Color fundus photograph. 1659 by 2212 pixels — 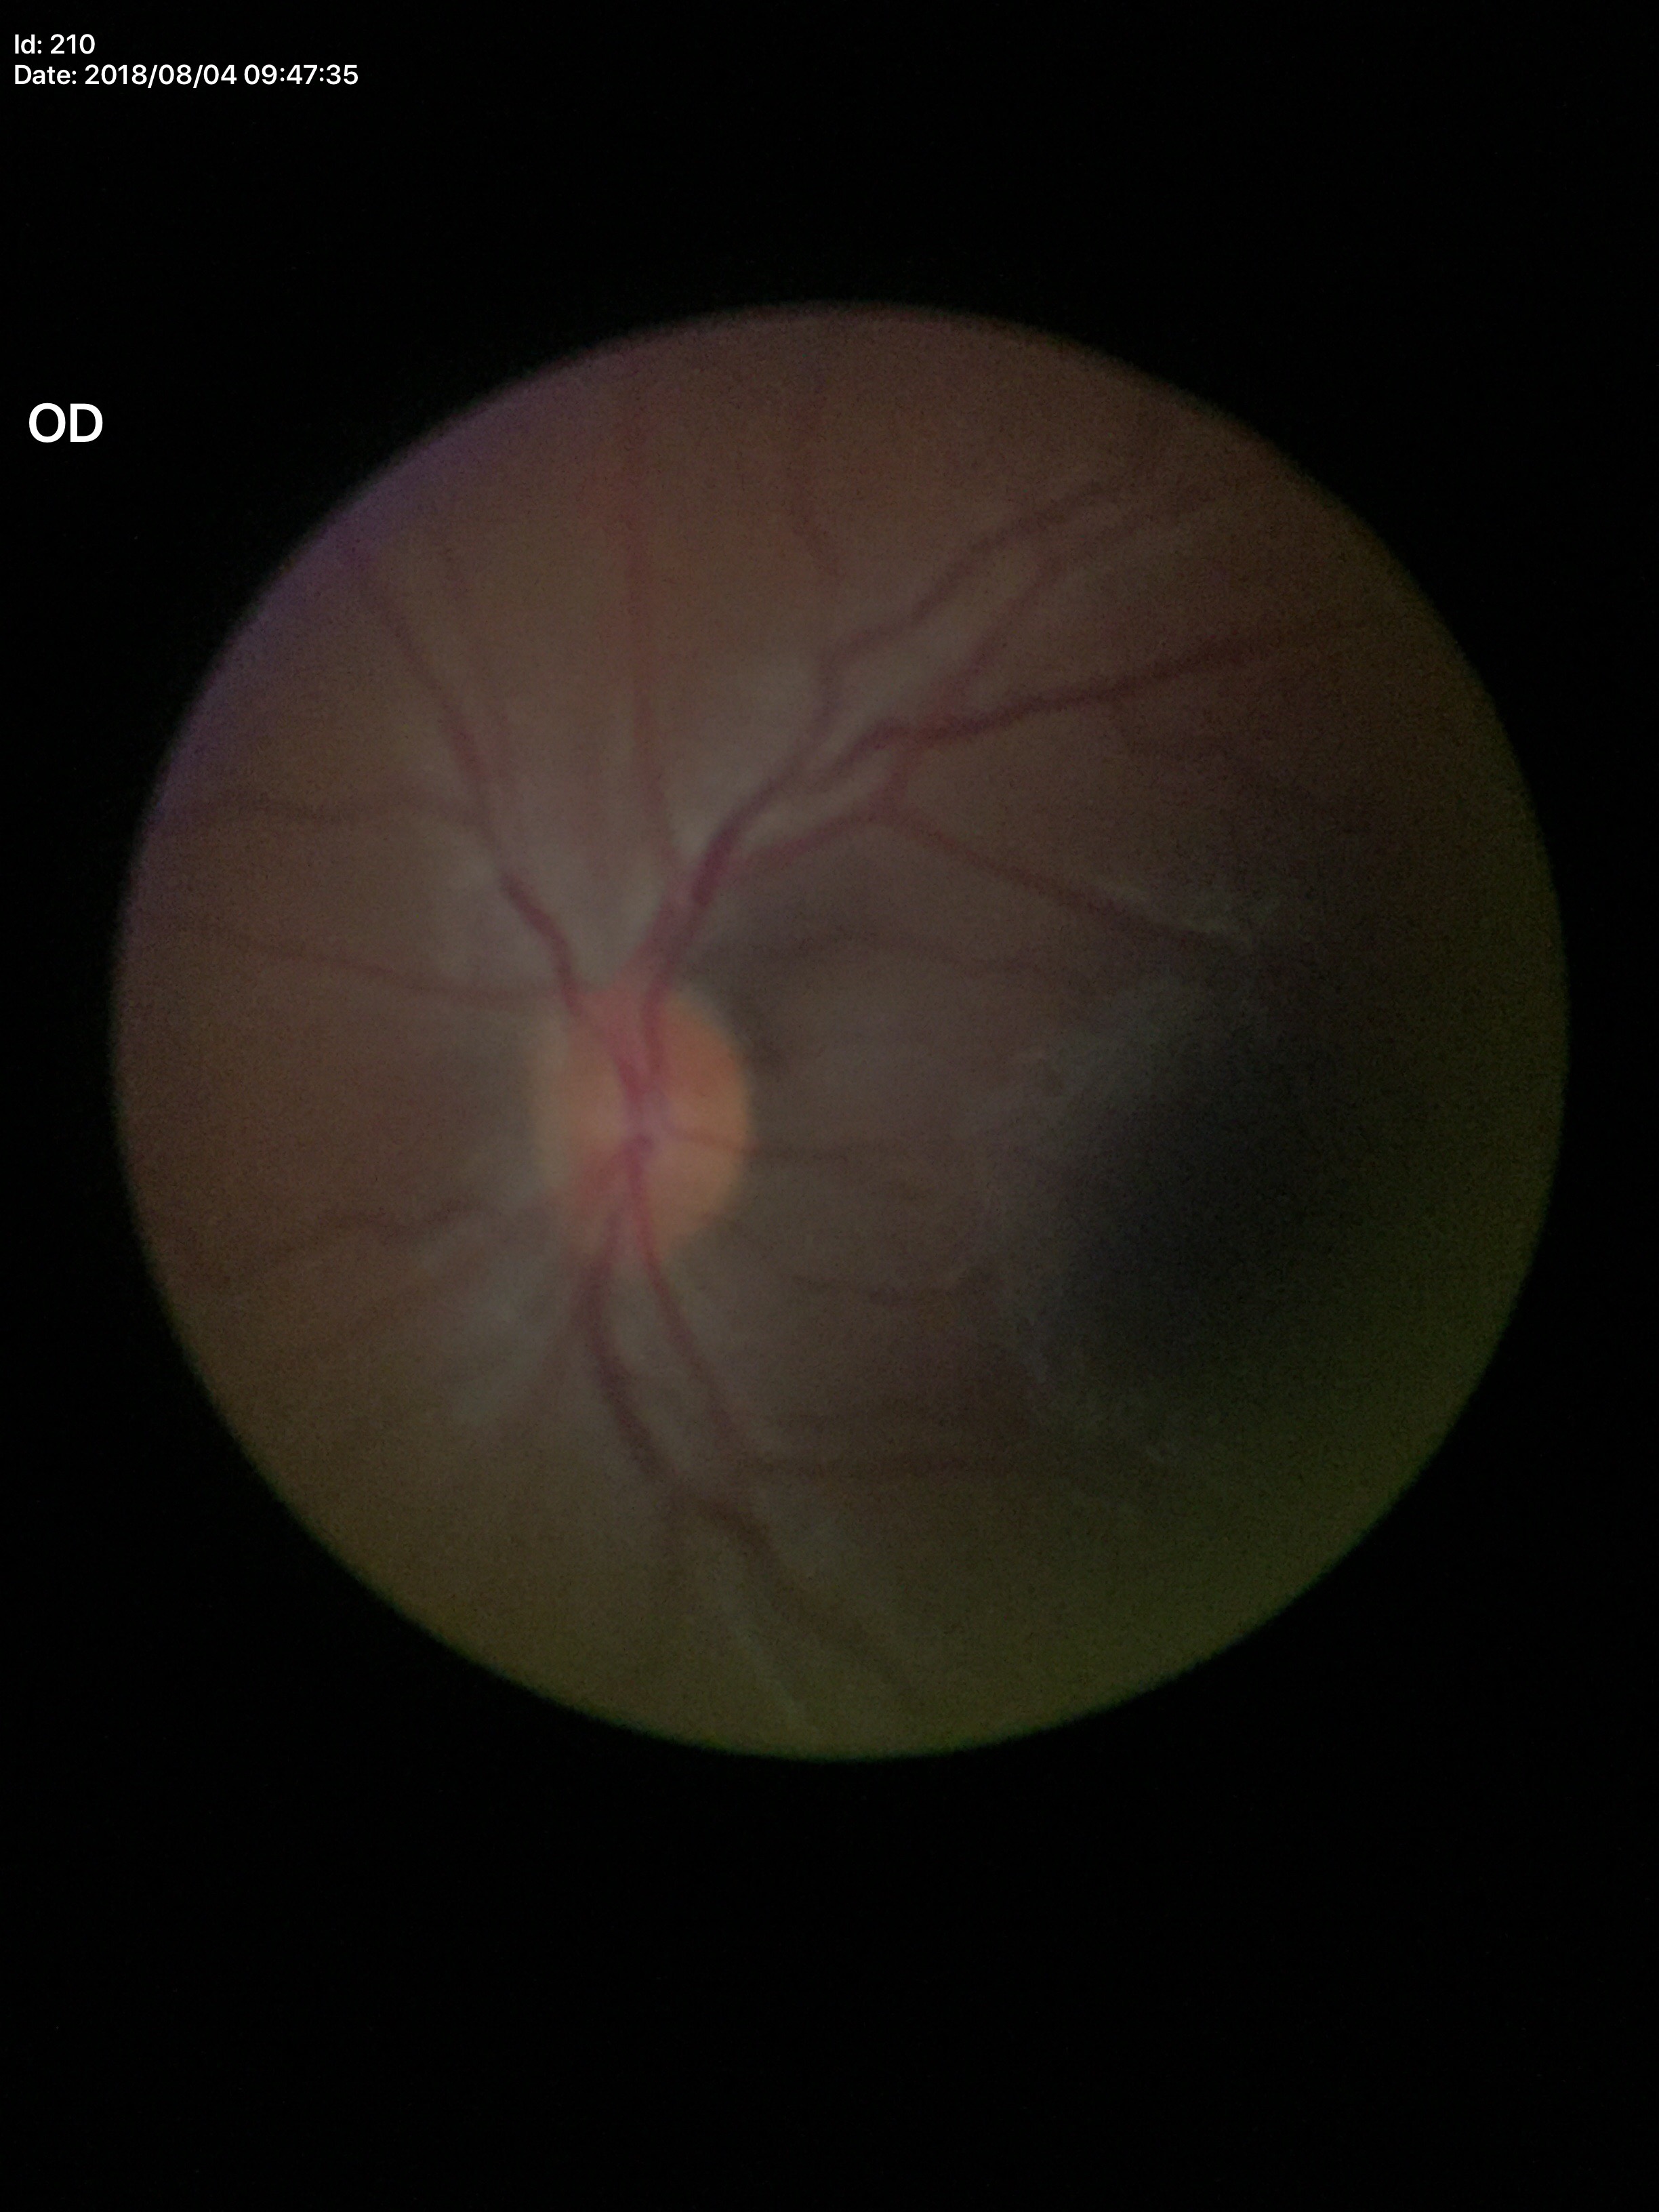 Q: Is there glaucoma suspicion?
A: not suspect
Q: What is the VCDR?
A: 0.46